640 x 480 pixels; wide-field contact fundus photograph of an infant; Clarity RetCam 3, 130° FOV
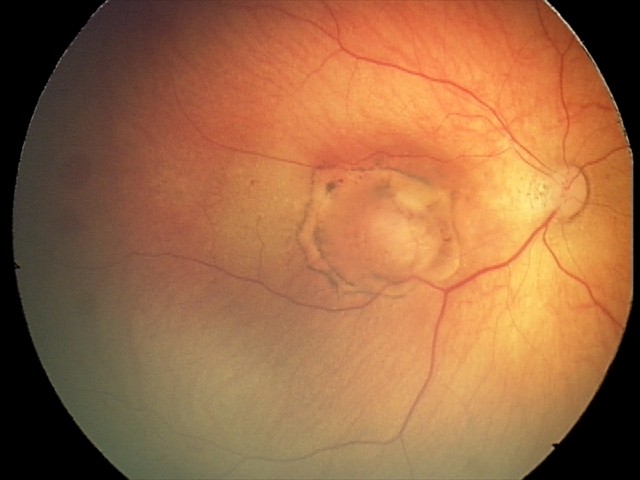
Diagnosis = toxoplasmosis chorioretinitis.